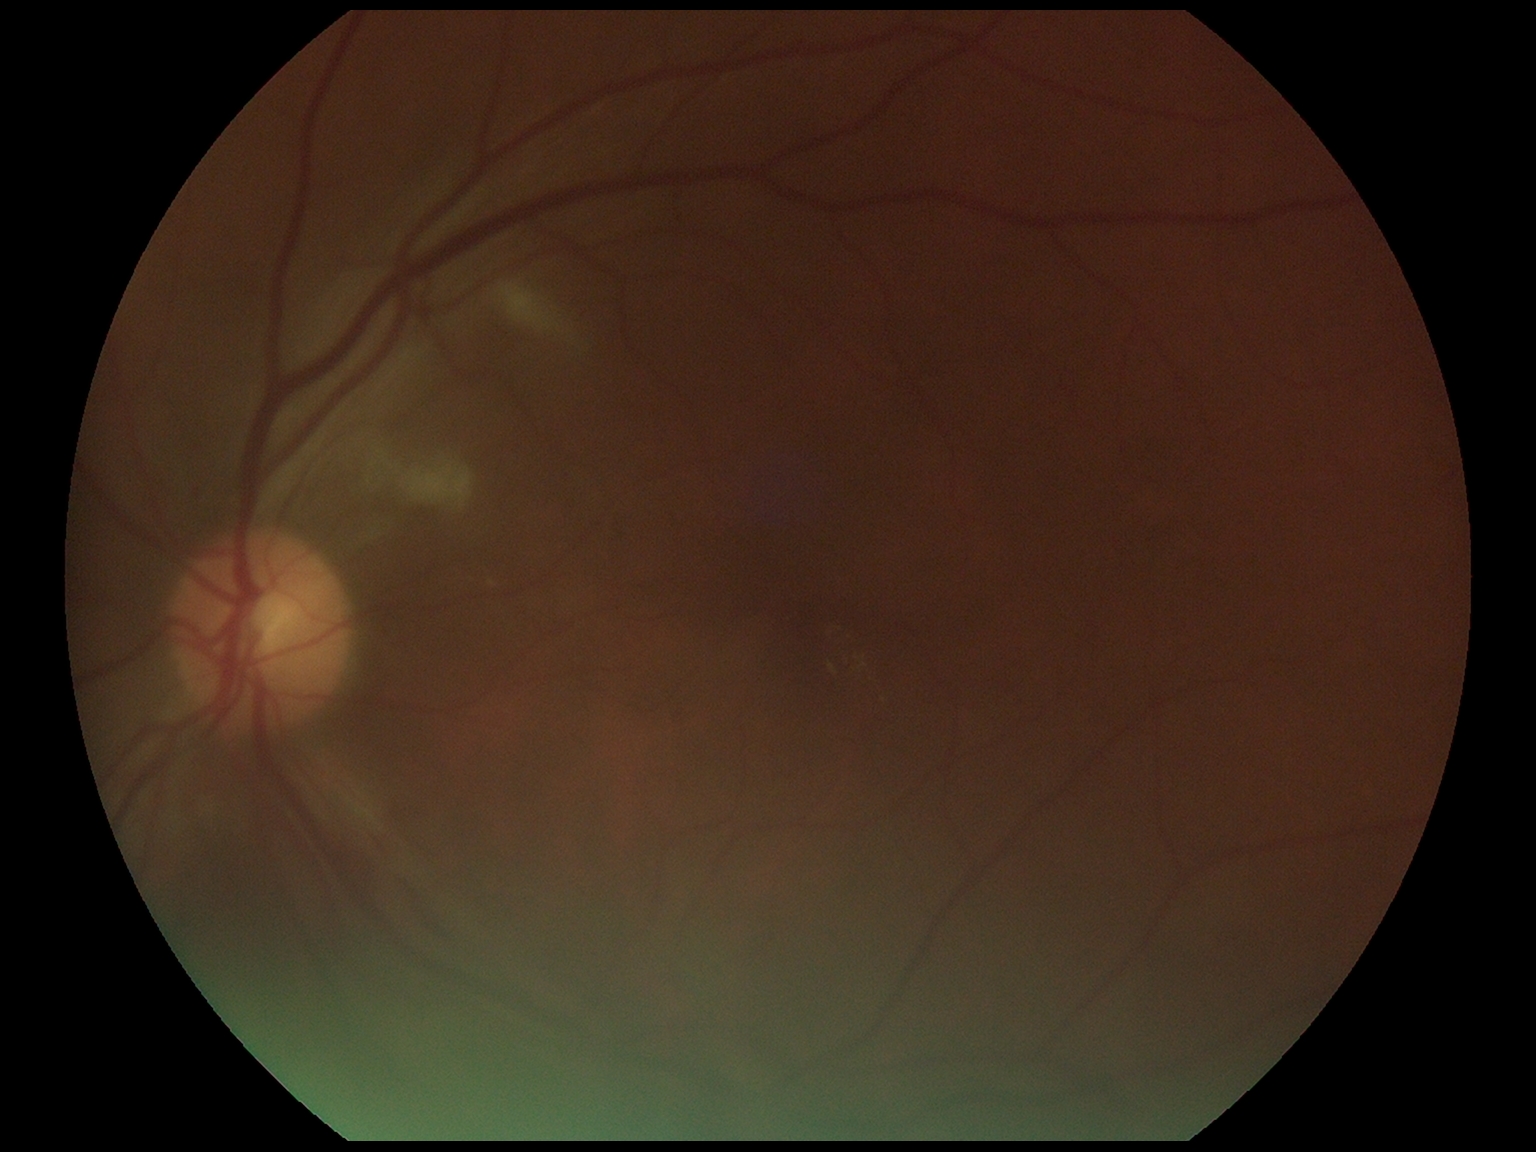
{"dr_grade": "grade 2", "dr_category": "non-proliferative diabetic retinopathy"}